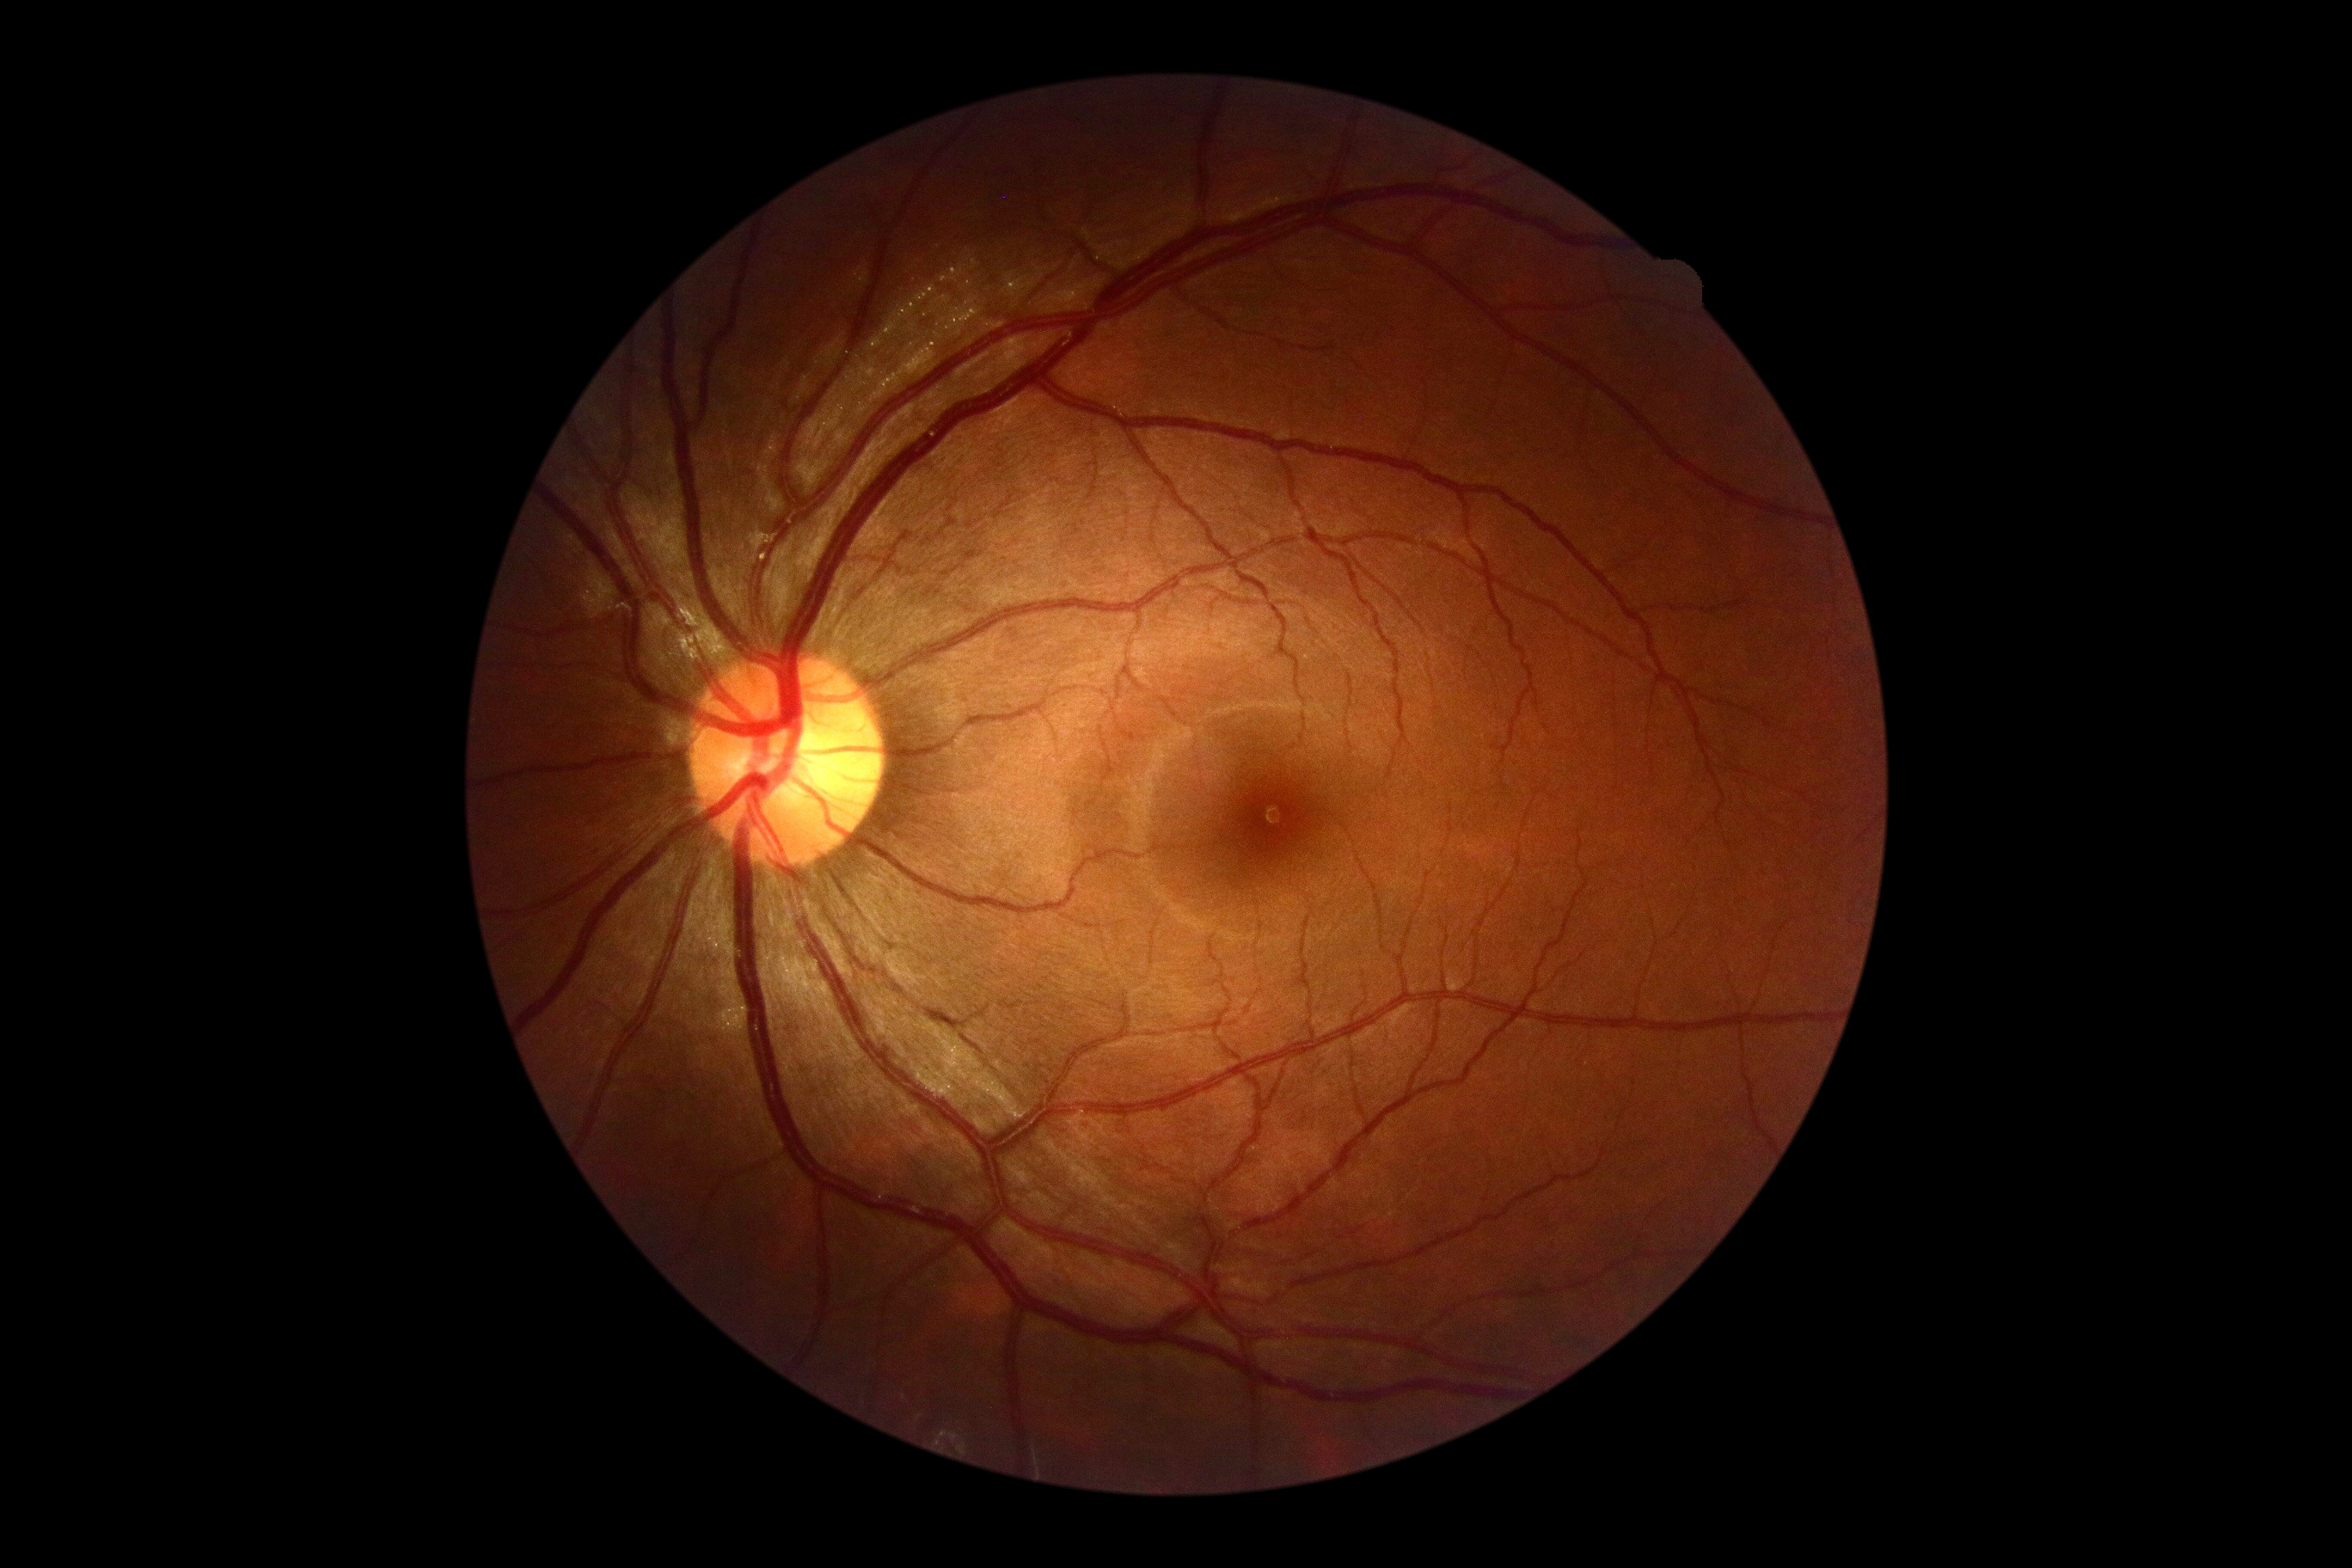

diabetic retinopathy (DR): grade 0.